Color fundus image. Modified Davis classification. 848 x 848 pixels — 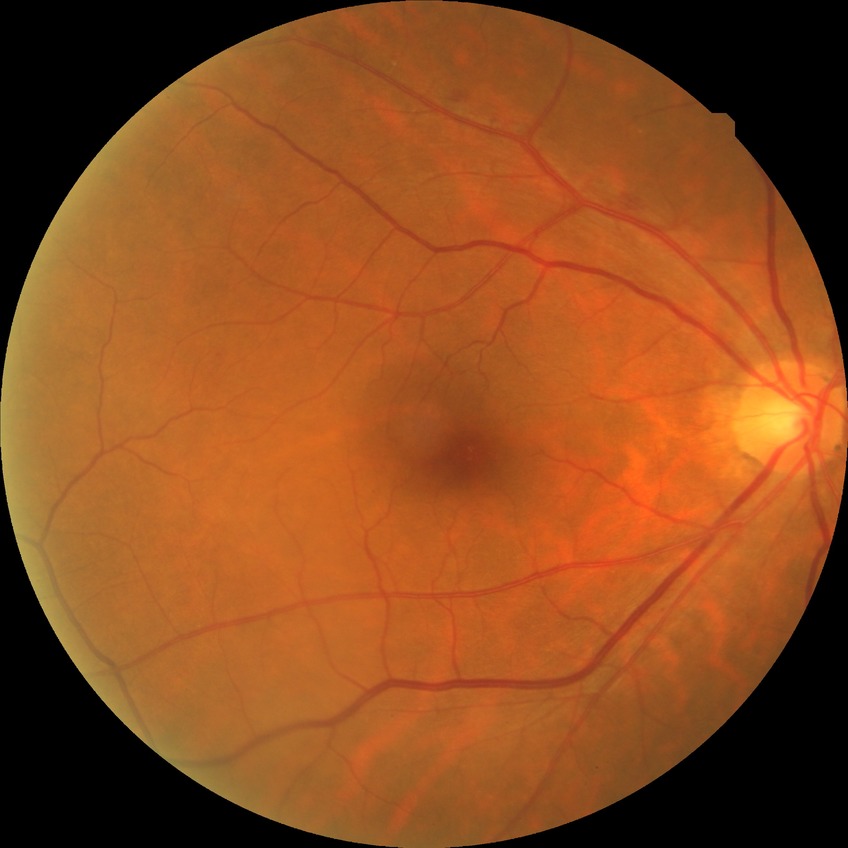

Assessment:
• modified Davis grading: simple diabetic retinopathy
• DR class: non-proliferative diabetic retinopathy